2352 by 1568 pixels. Color fundus photograph:
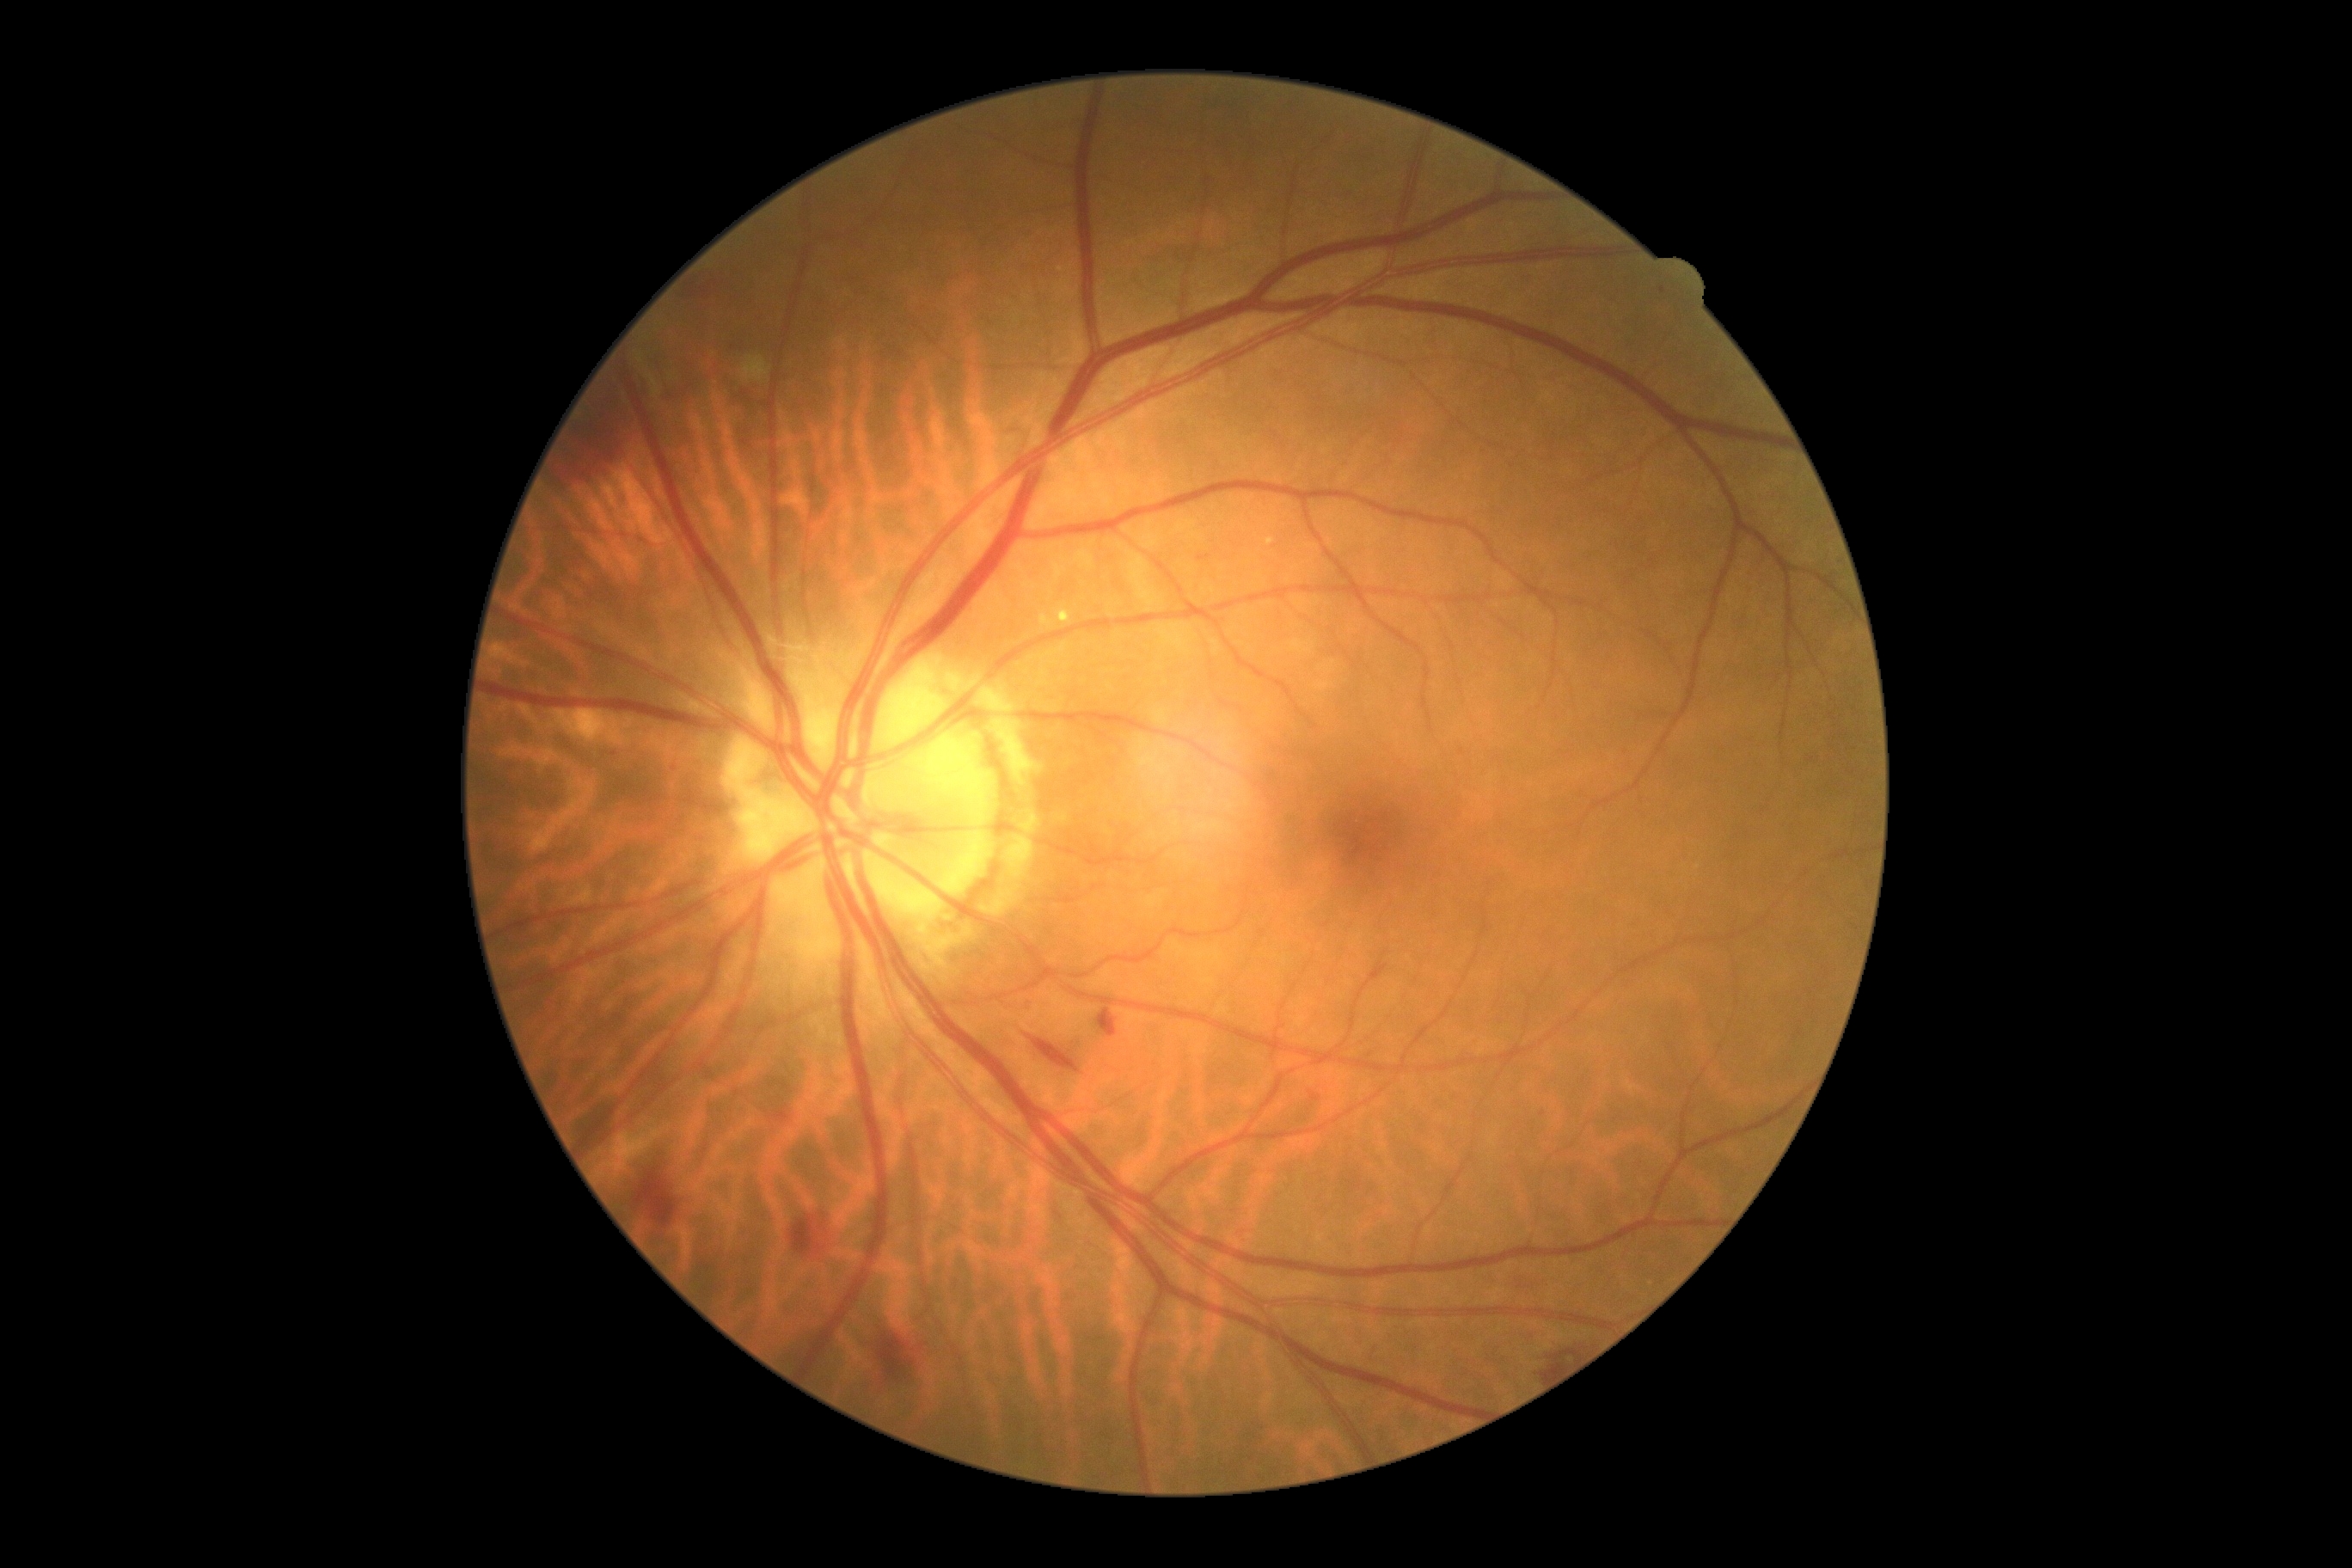

{"dr_grade": "2", "dr_category": "non-proliferative diabetic retinopathy"}